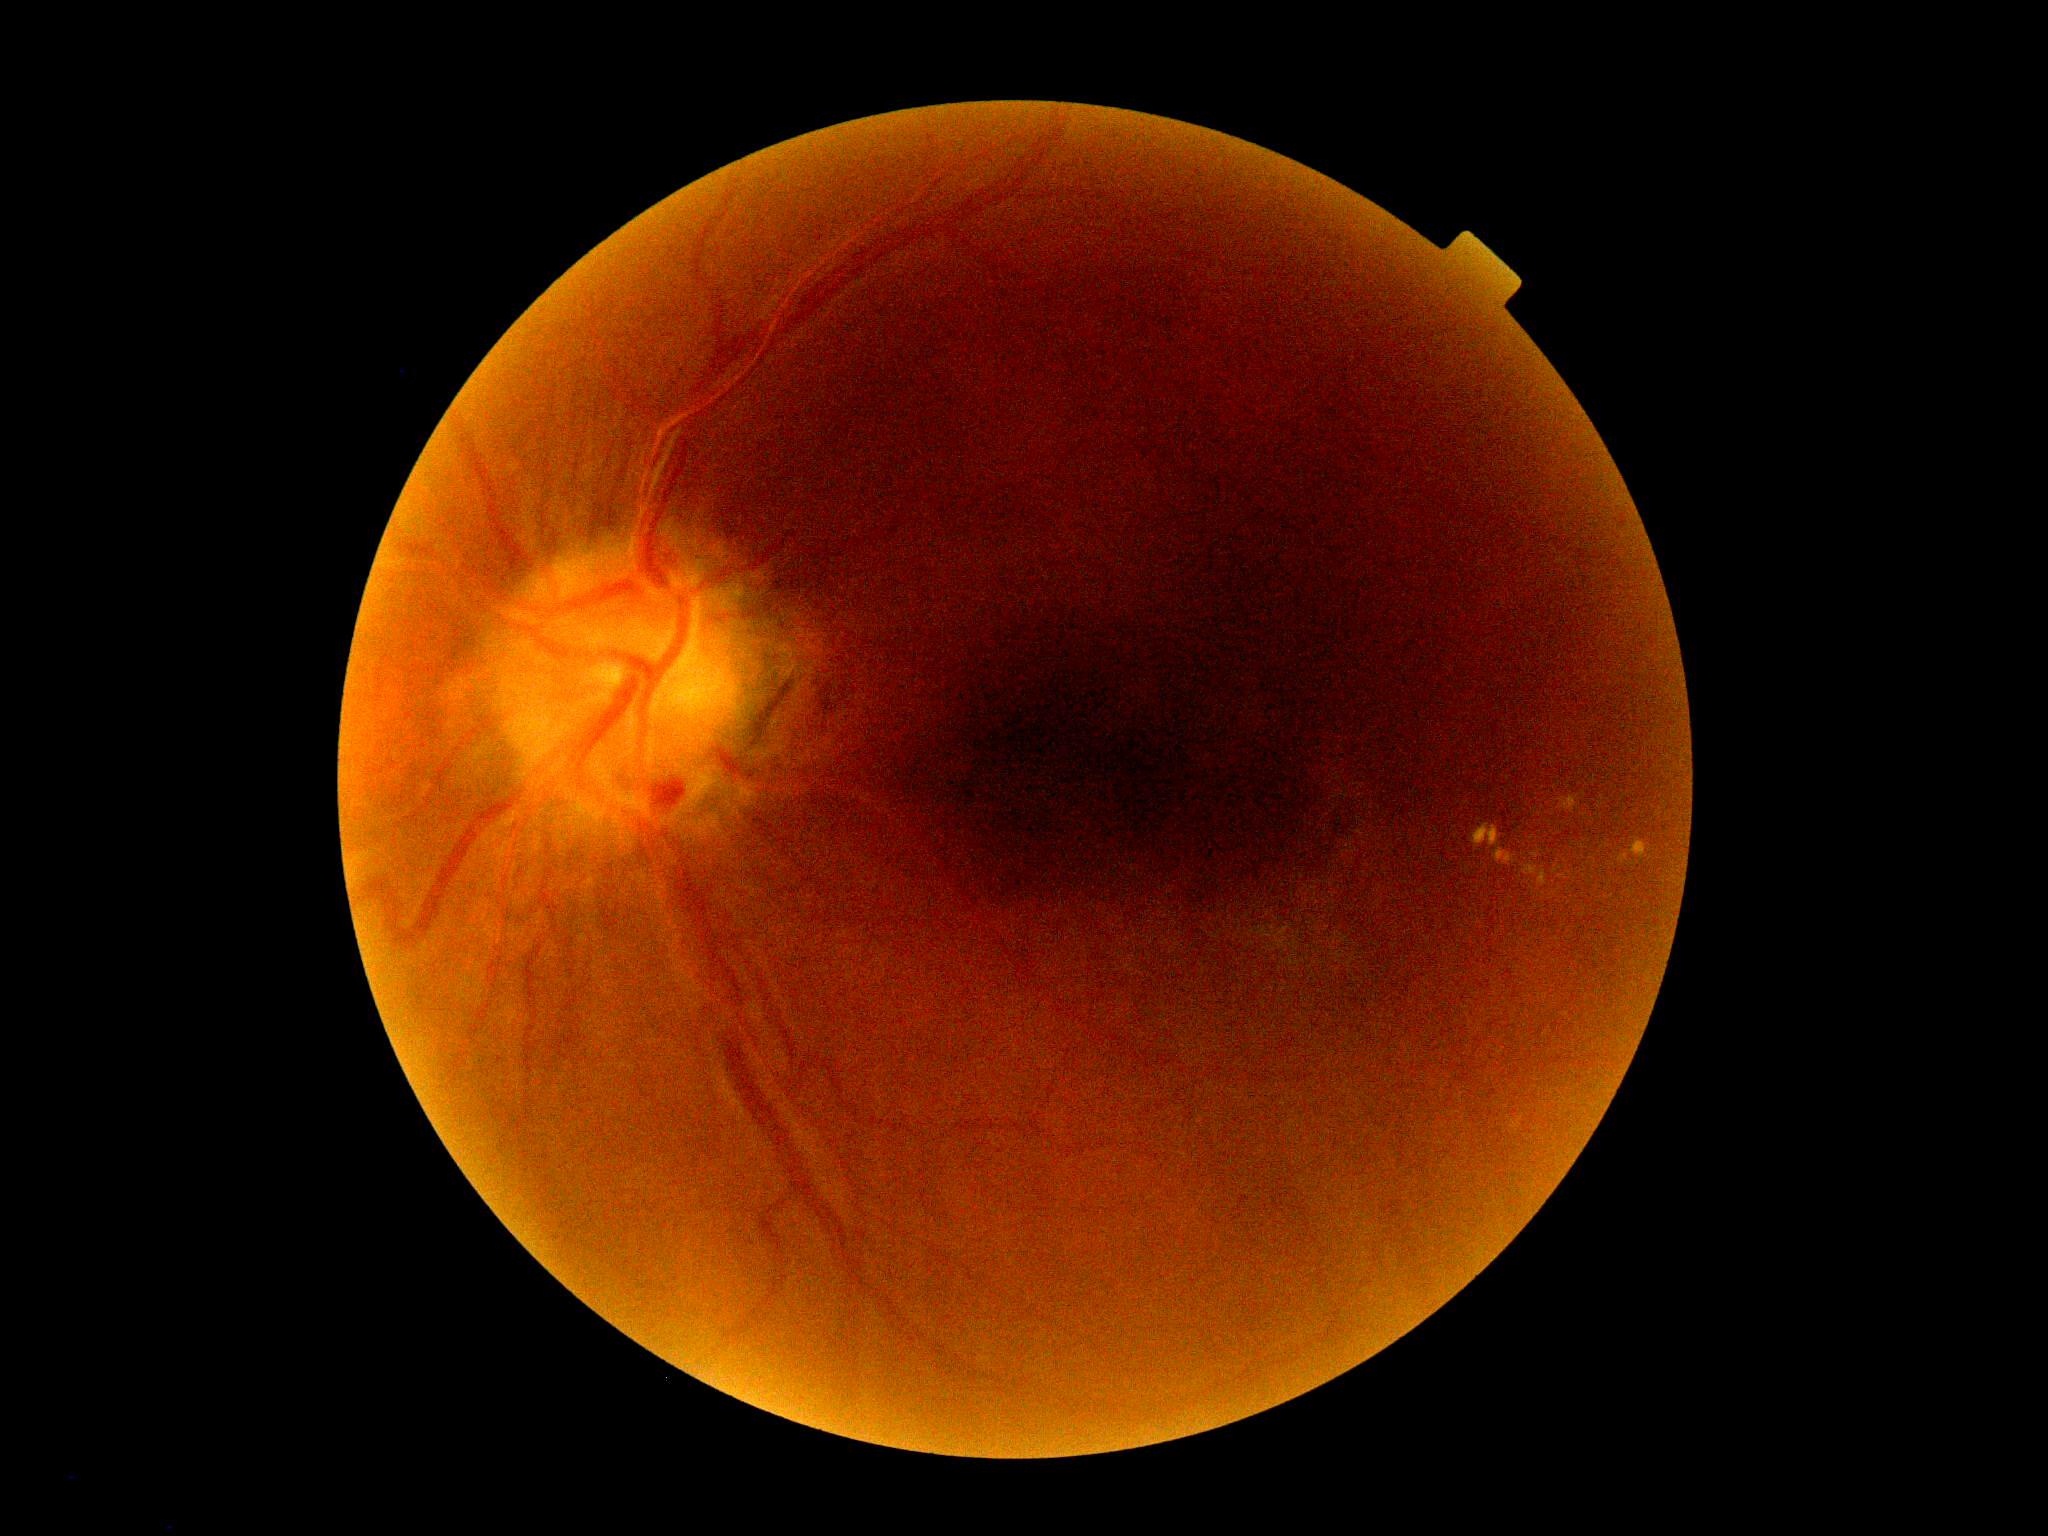
Diabetic retinopathy (DR) is grade 2 (moderate NPDR).